1240x1240px; wide-field fundus photograph of an infant; 100° field of view (Phoenix ICON):
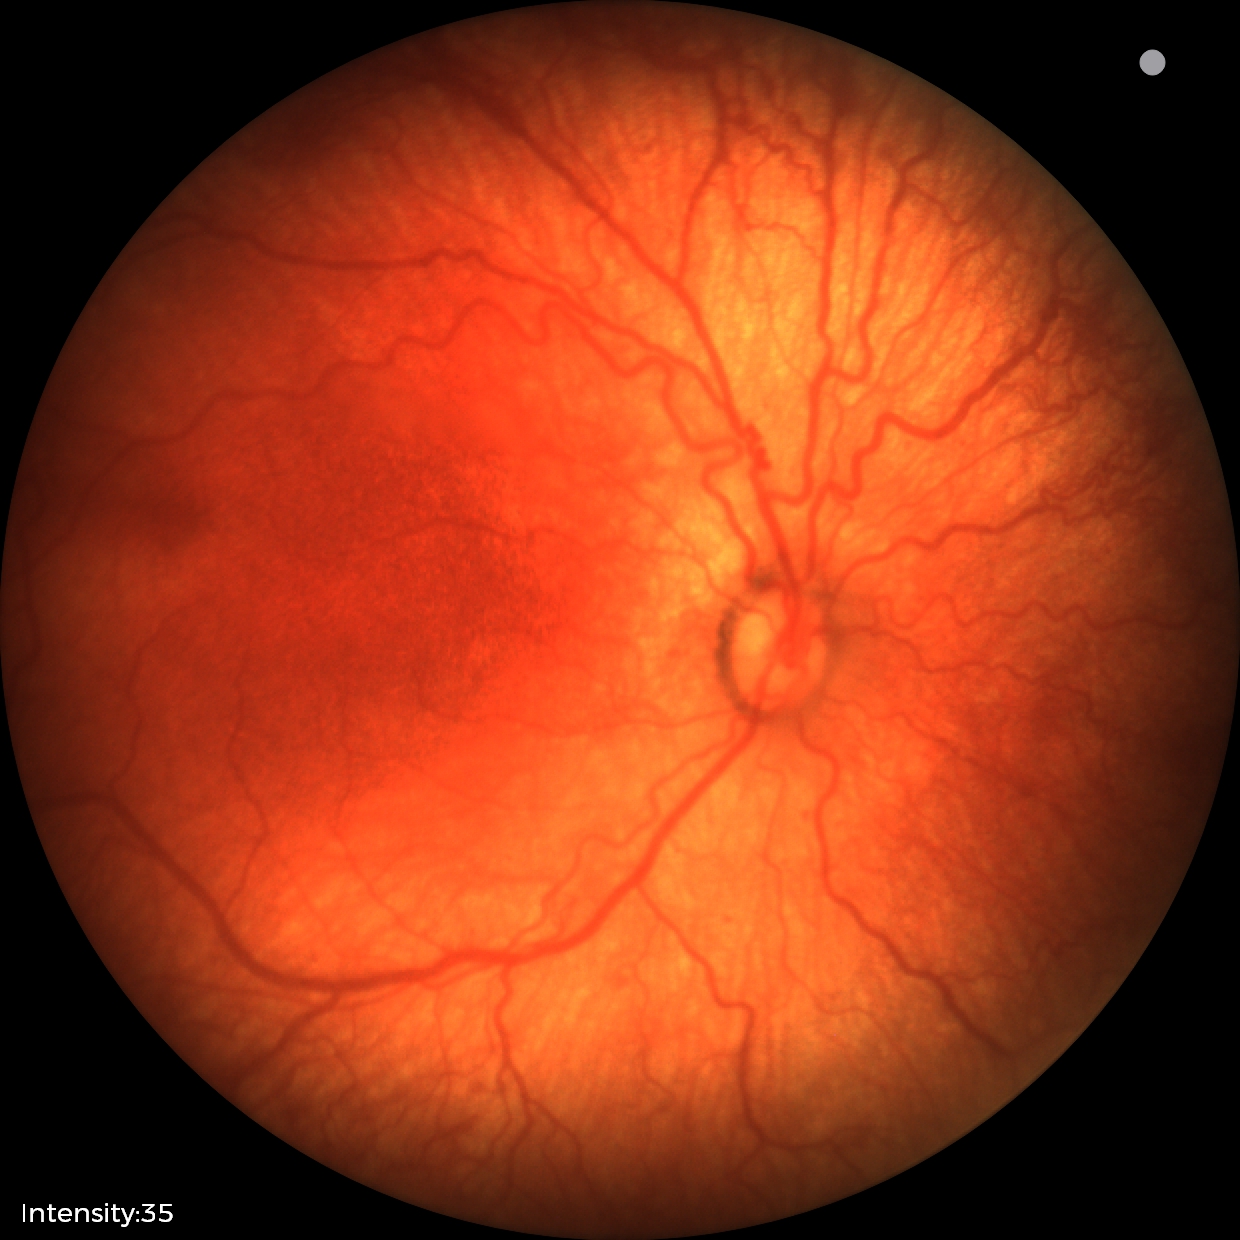
Examination diagnosed as ROP stage 1.